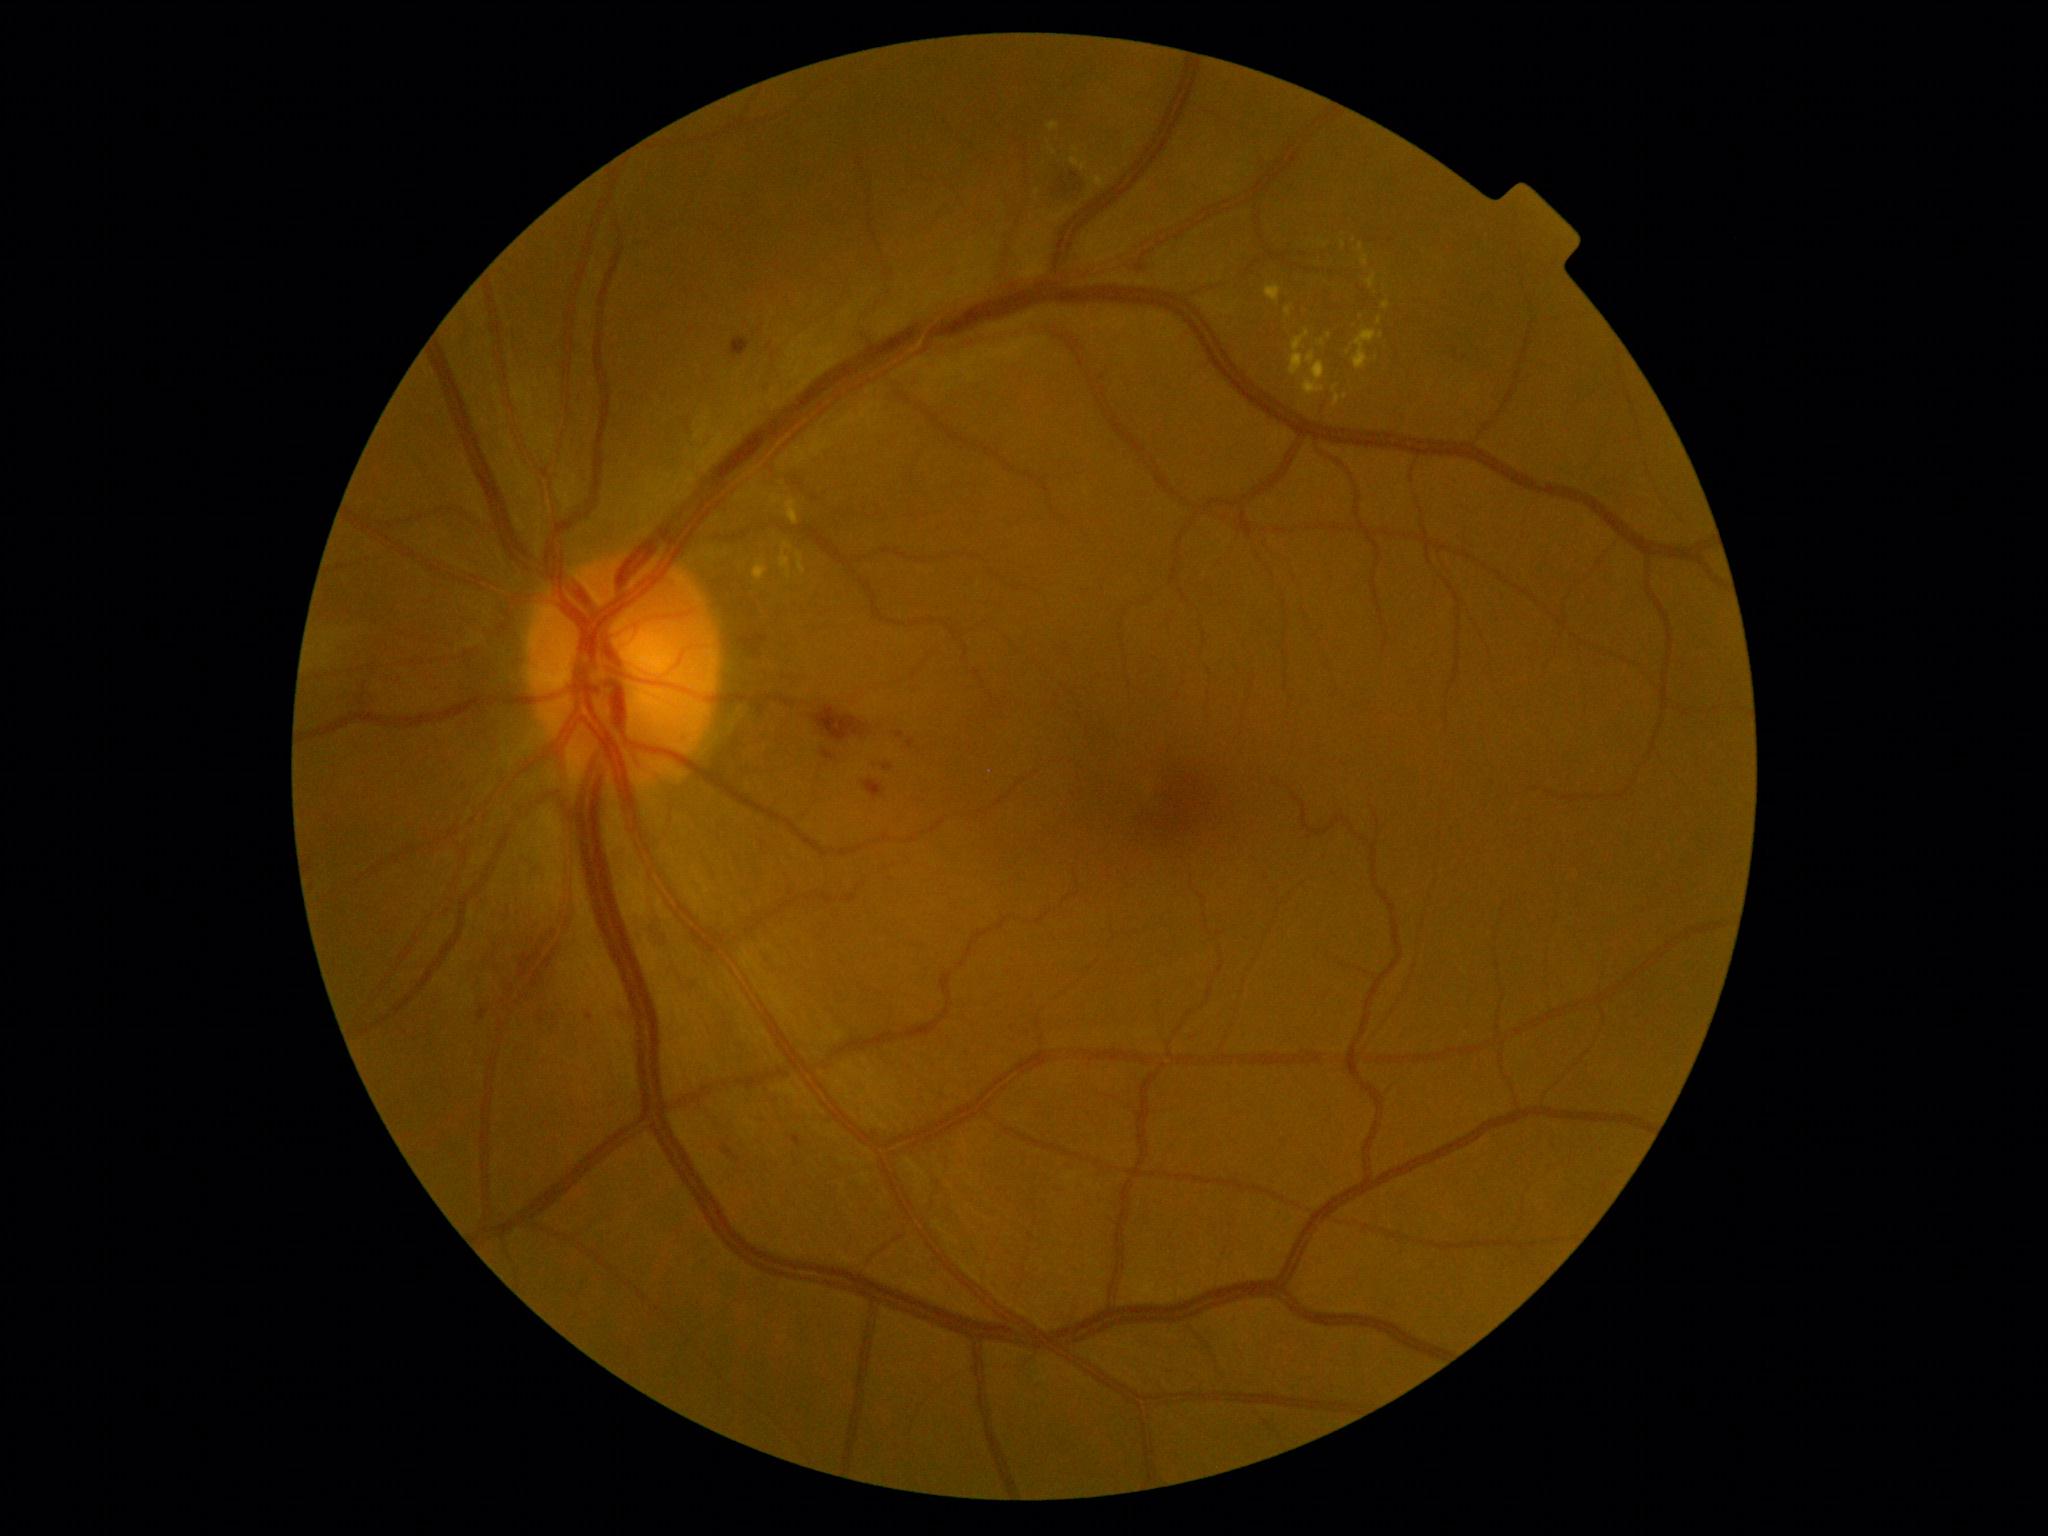 <lesions partial="true">
  <dr_grade>2</dr_grade>
  <ex partial="true">[1362,255,1369,266] | [1266,285,1282,304] | [1071,159,1088,170] | [754,563,766,574] | [780,541,793,580] | [1286,308,1292,318] | [1377,317,1382,325] | [1333,385,1340,407] | [1290,329,1326,397]</ex>
  <ex_small>(1329, 336) | (1344, 245)</ex_small>
  <he>[730,338,750,359] | [823,752,834,760] | [724,1146,733,1156] | [883,765,893,770] | [1045,169,1082,205] | [813,706,867,743] | [862,779,887,800]</he>
  <se />
  <ma>[908,739,915,749] | [478,1009,489,1021] | [896,732,905,739] | [794,1135,802,1144]</ma>
  <ma_small>(589, 1017)</ma_small>
</lesions>